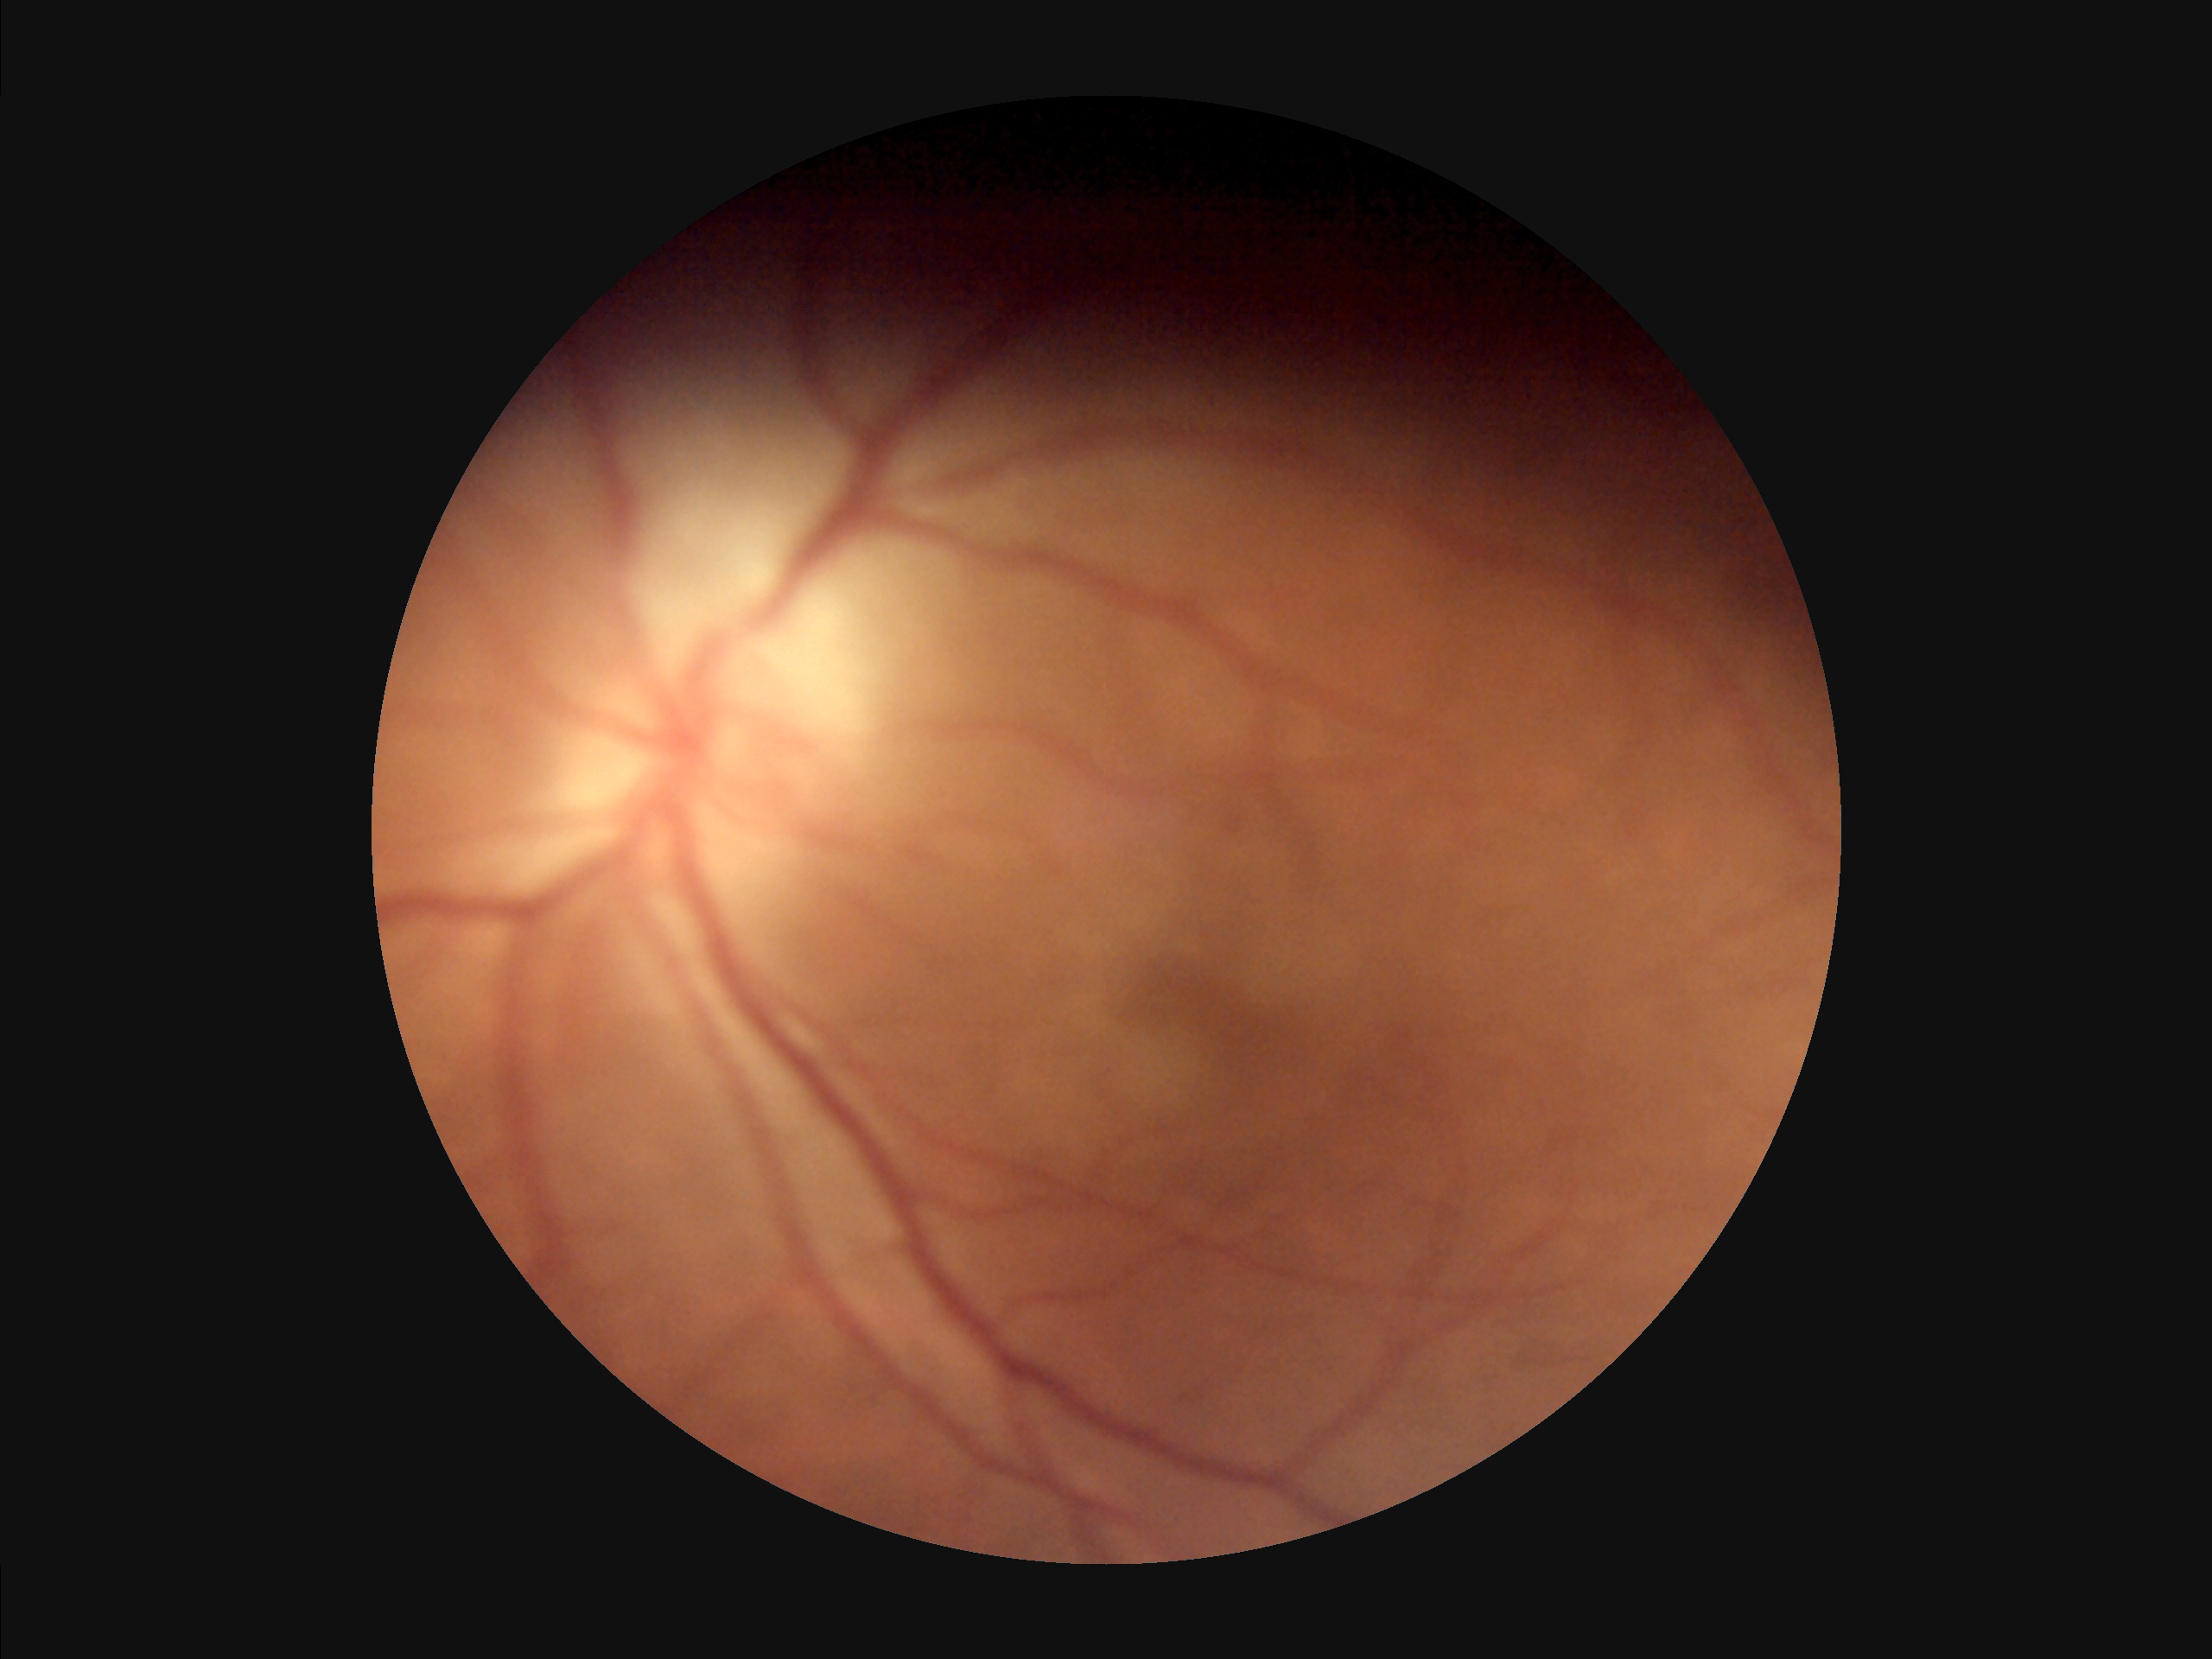

Reduced sharpness with visible blur. Vessels and details are hard to distinguish. Image quality is inadequate for diagnostic use. Illumination is even.